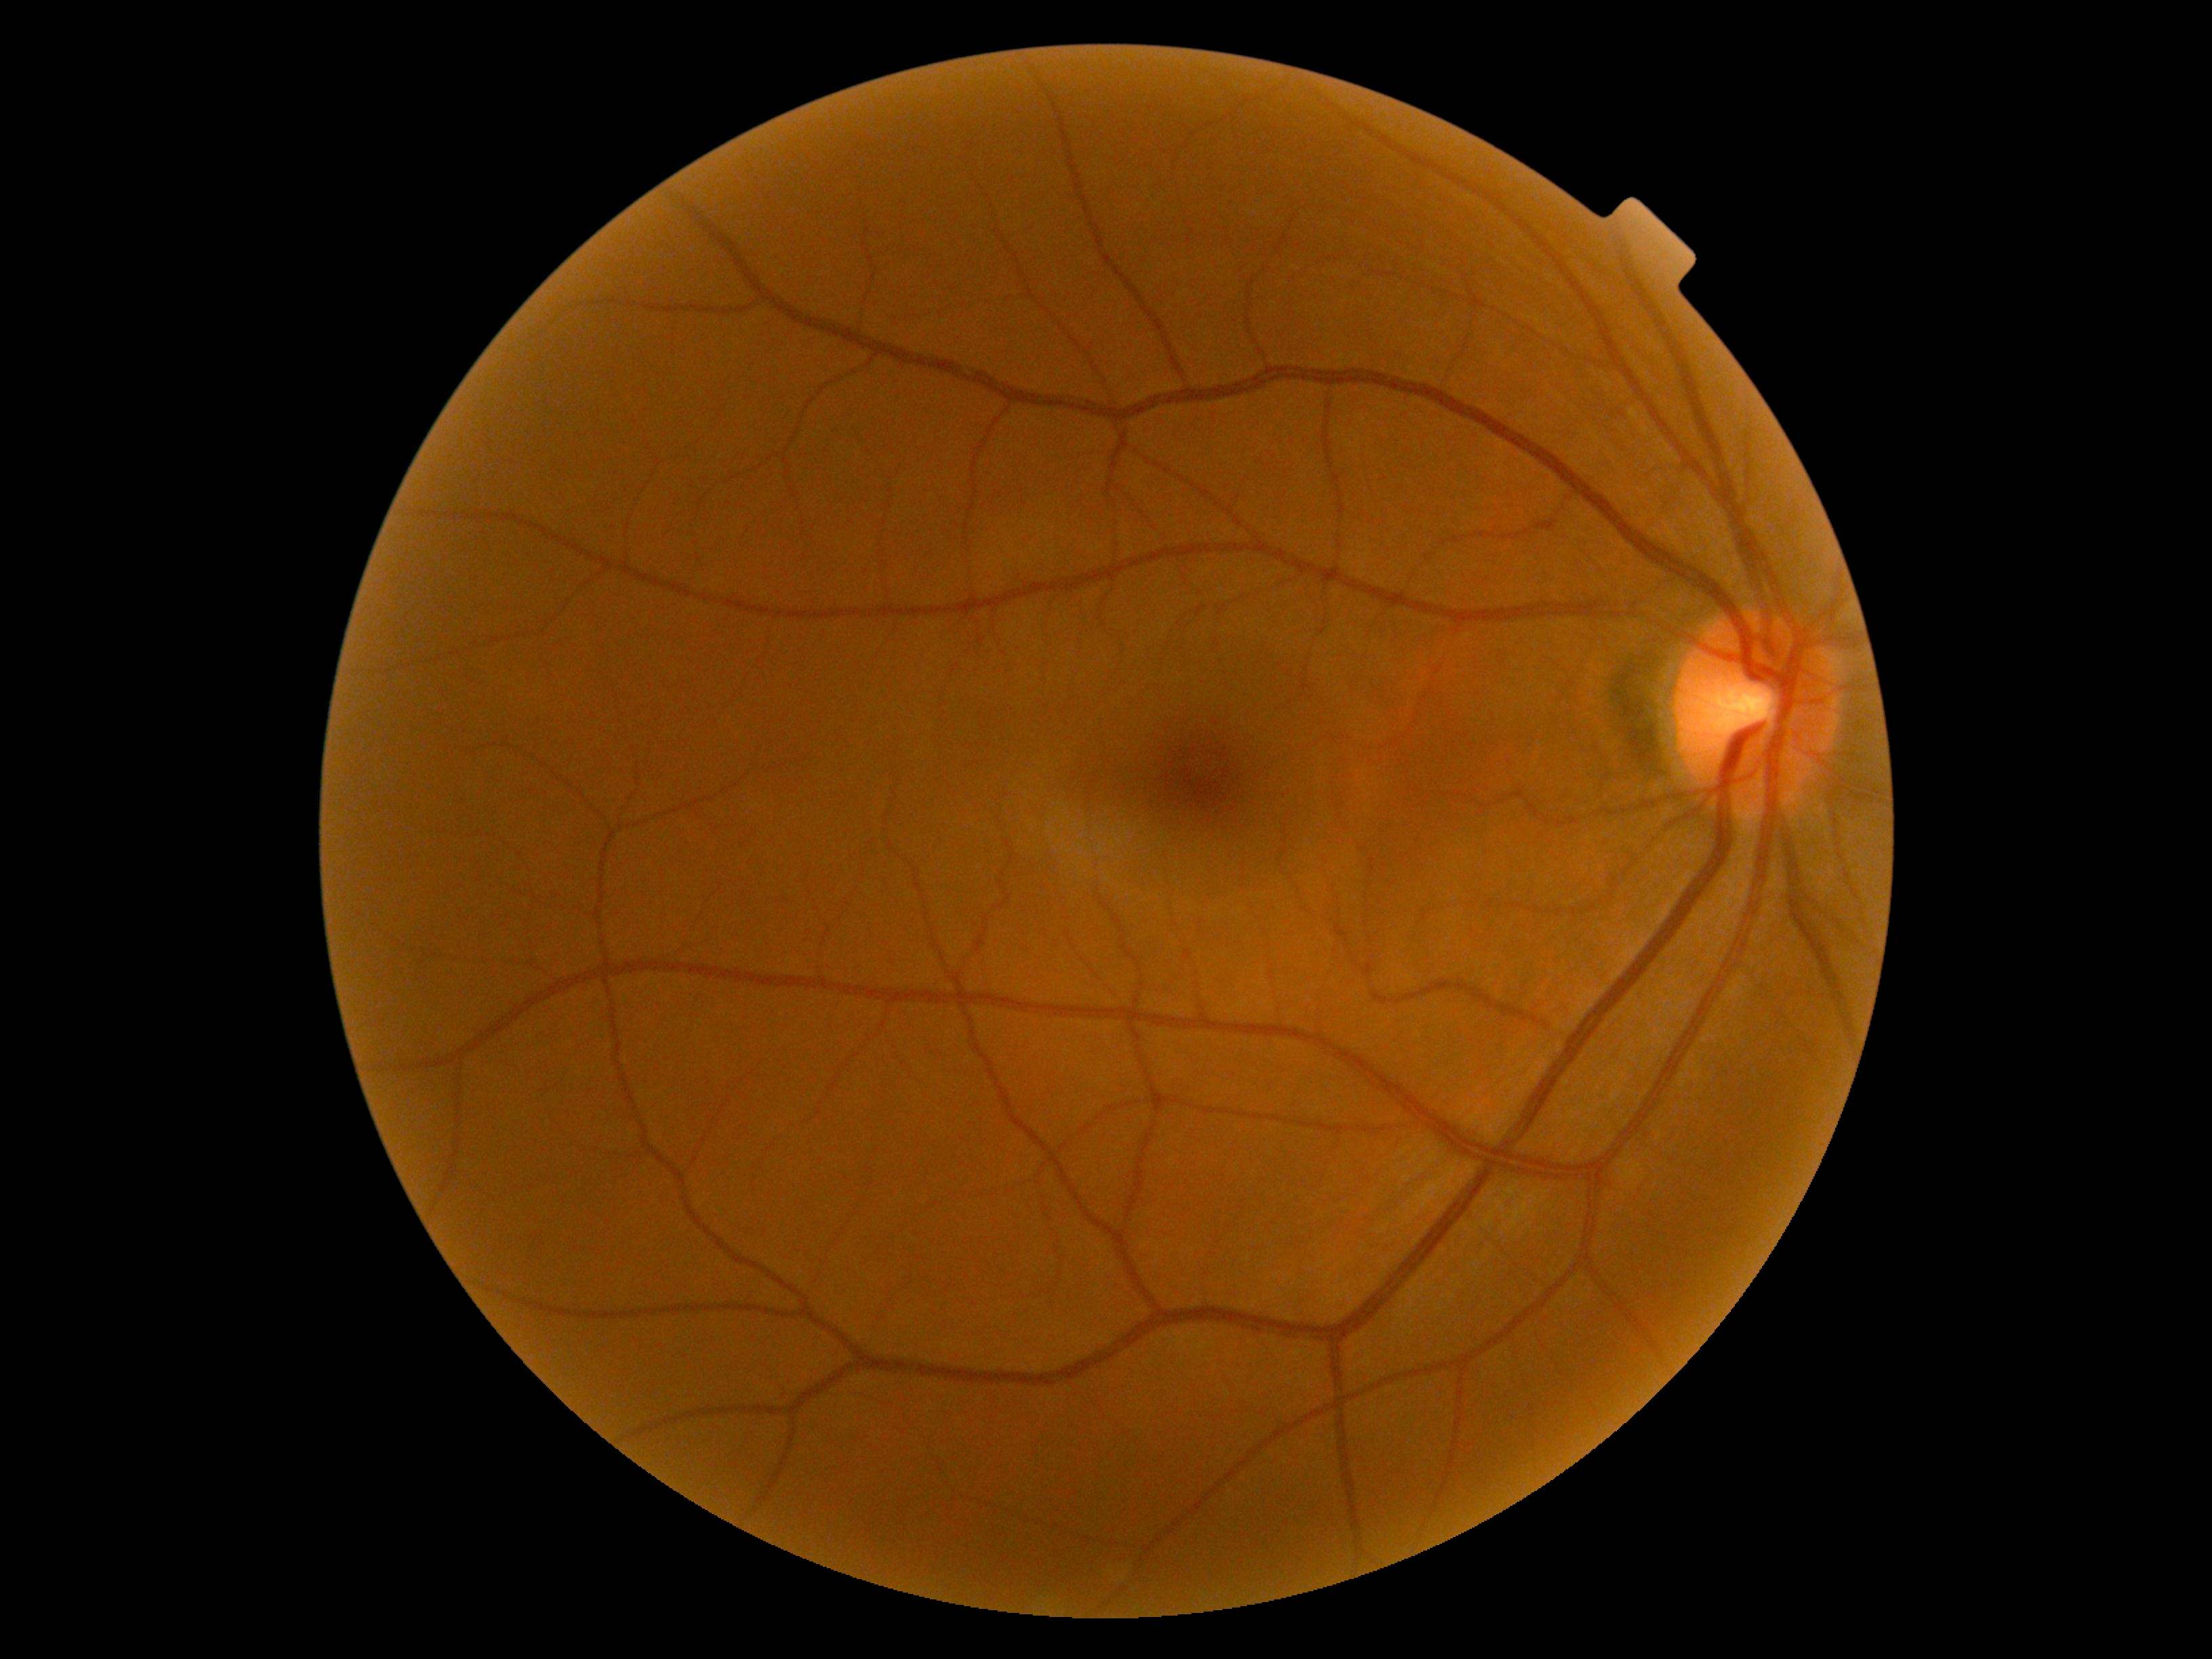

DR stage: no apparent retinopathy (grade 0).